1924 by 1556 pixels, FOV: 200 degrees, UWF retinal mosaic:
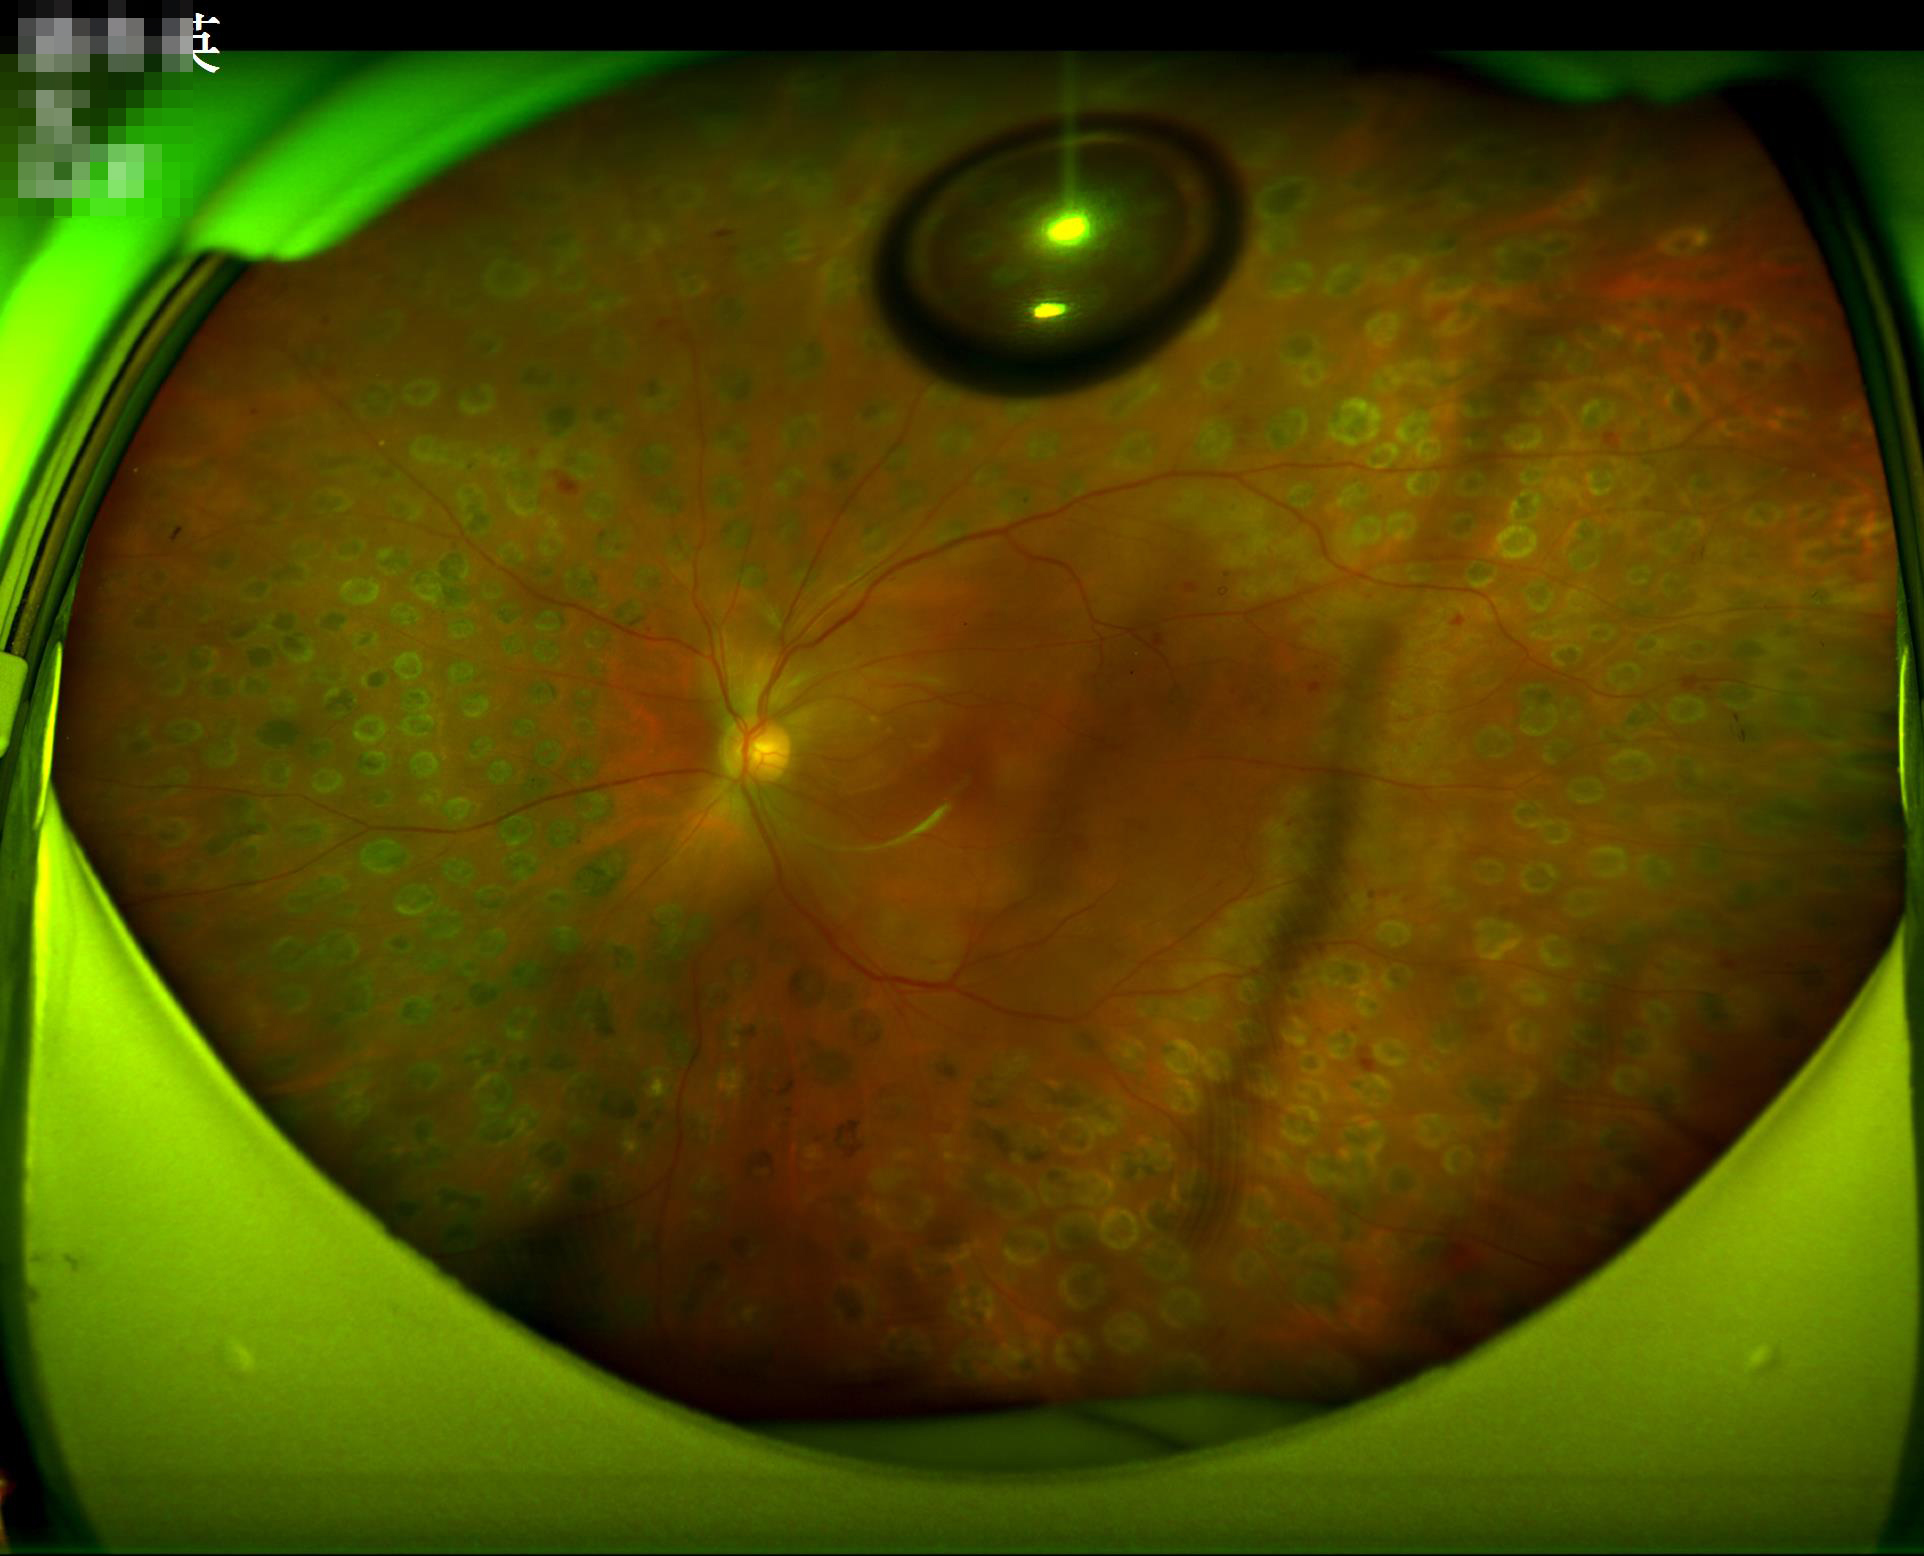

Sharpness: reduced sharpness with visible blur | Overall: poor, ungradable | Contrast: narrow intensity range, structures hard to distinguish | Illumination: no over- or under-exposure.